Color fundus image:
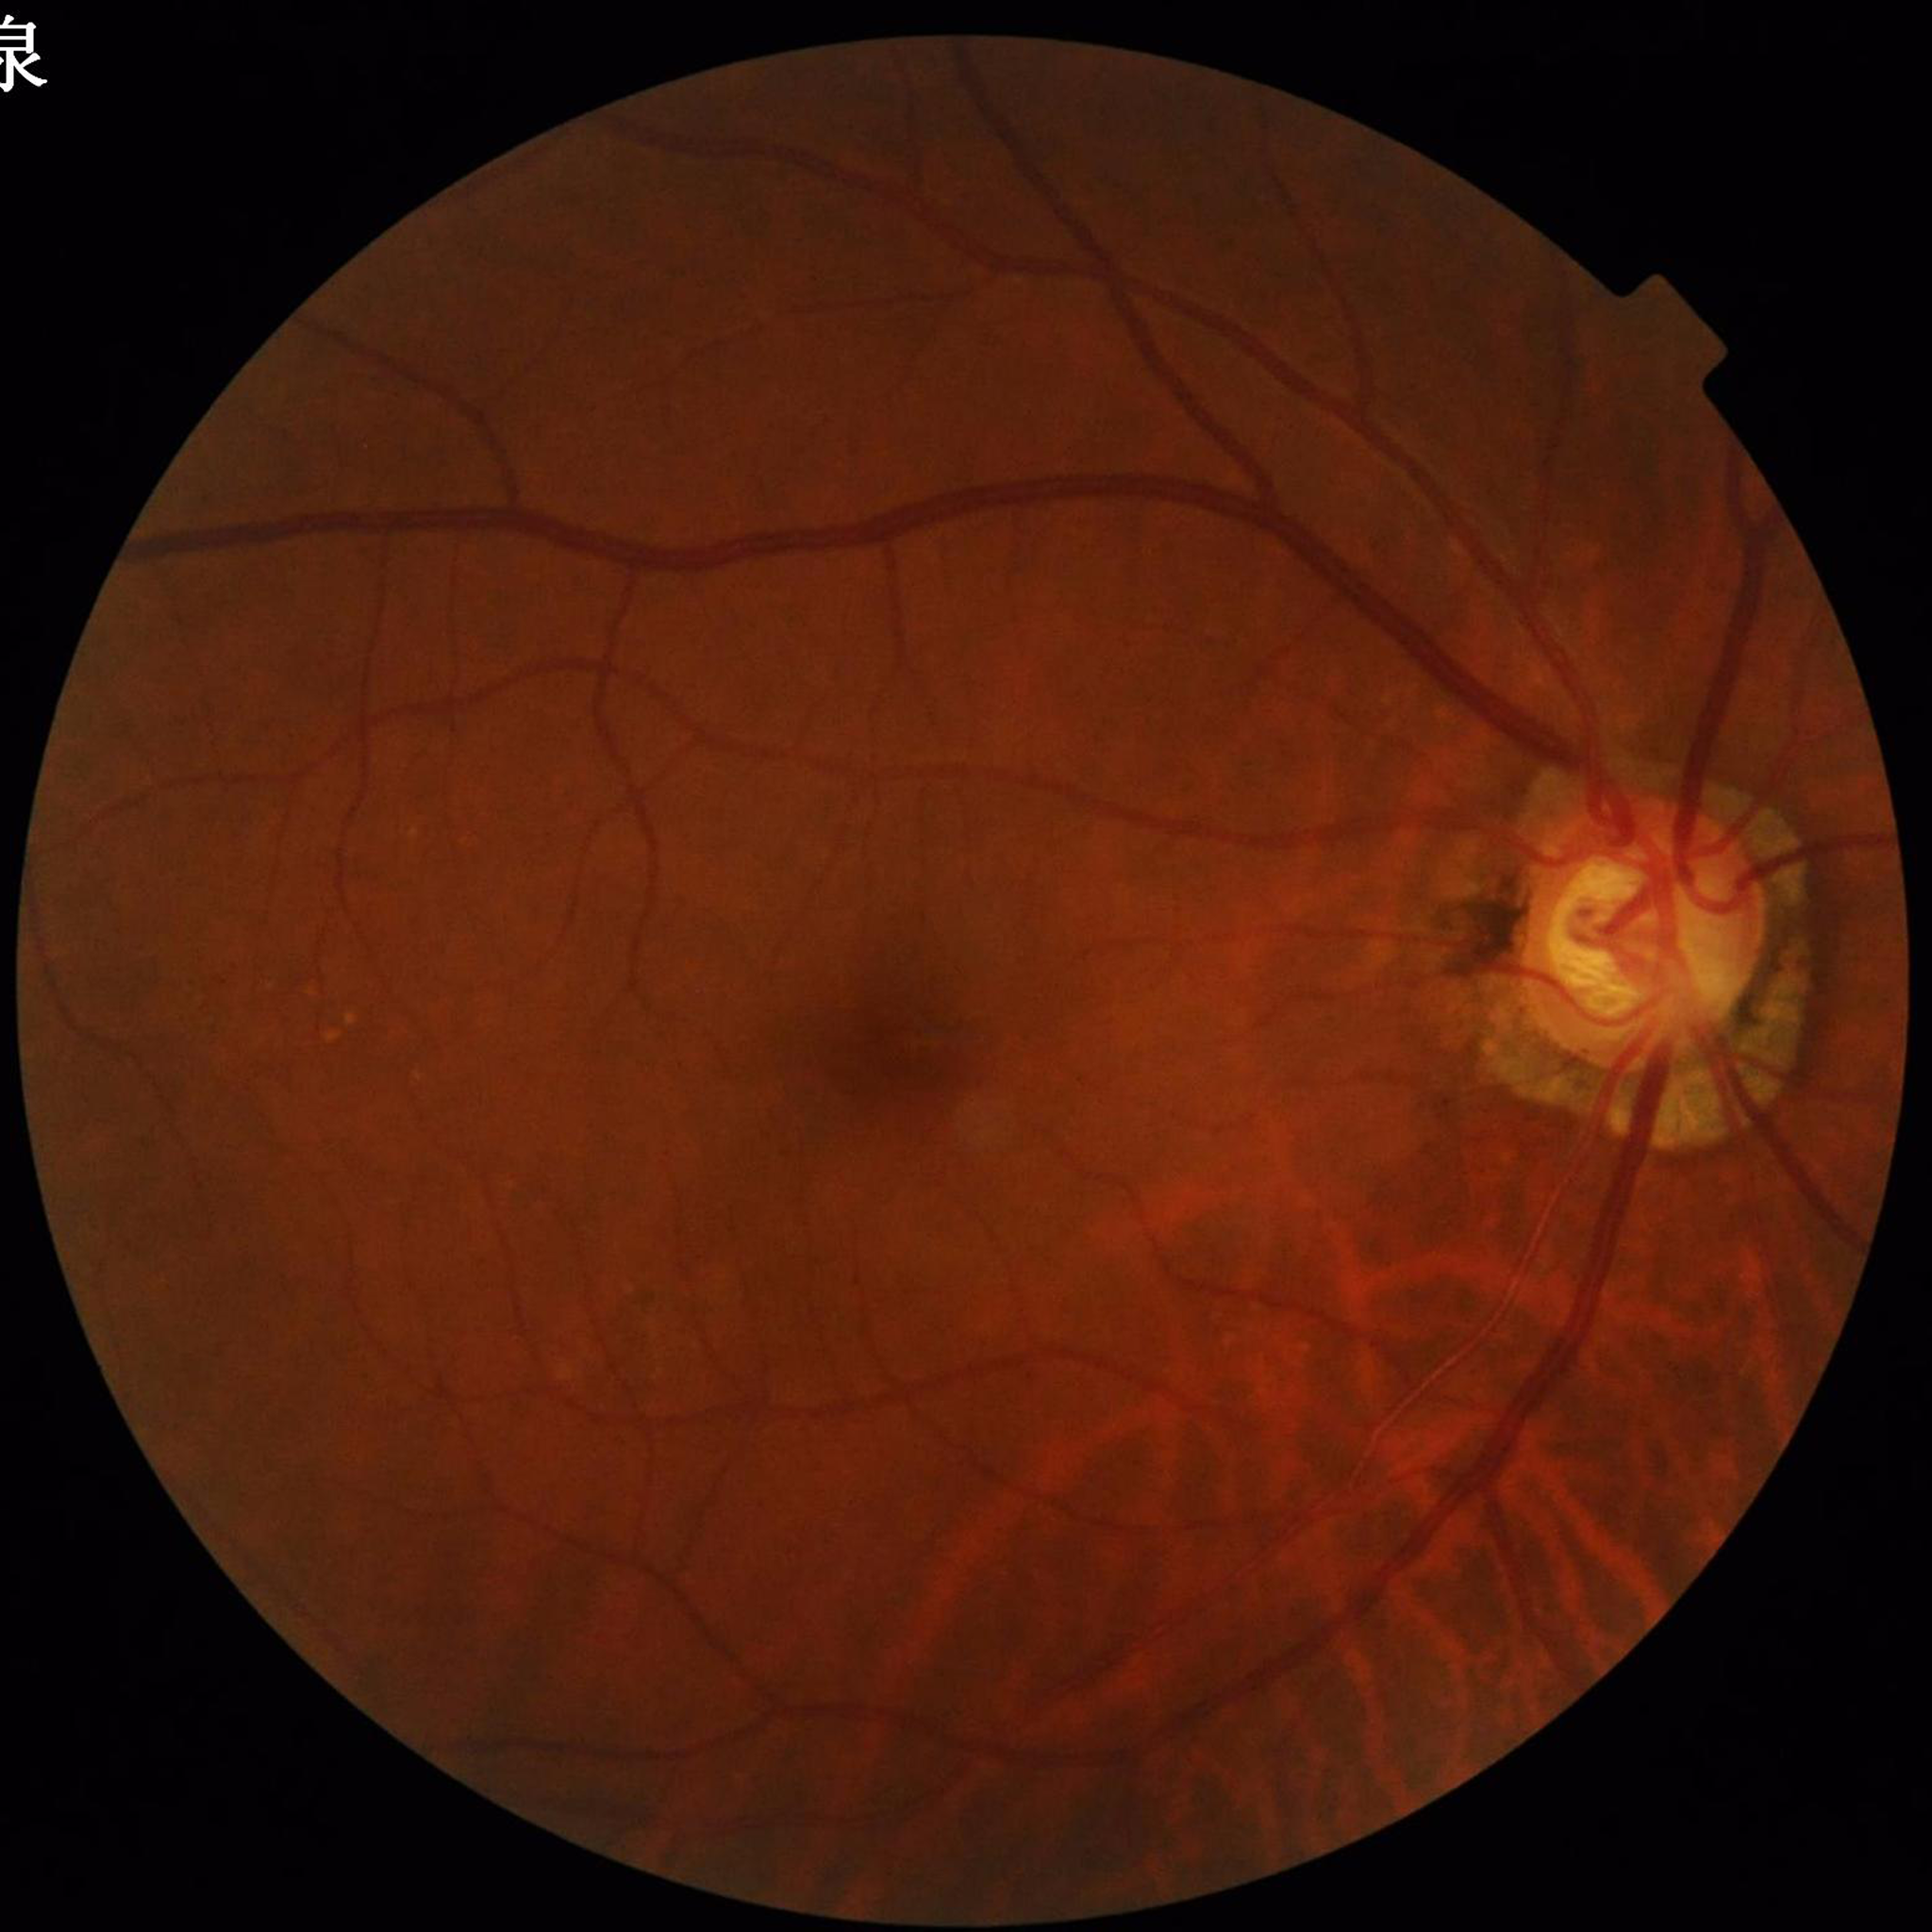

Automated quality assessment: no blur, illumination and color satisfactory, contrast adequate; Impression: glaucoma.